2352 by 1568 pixels: 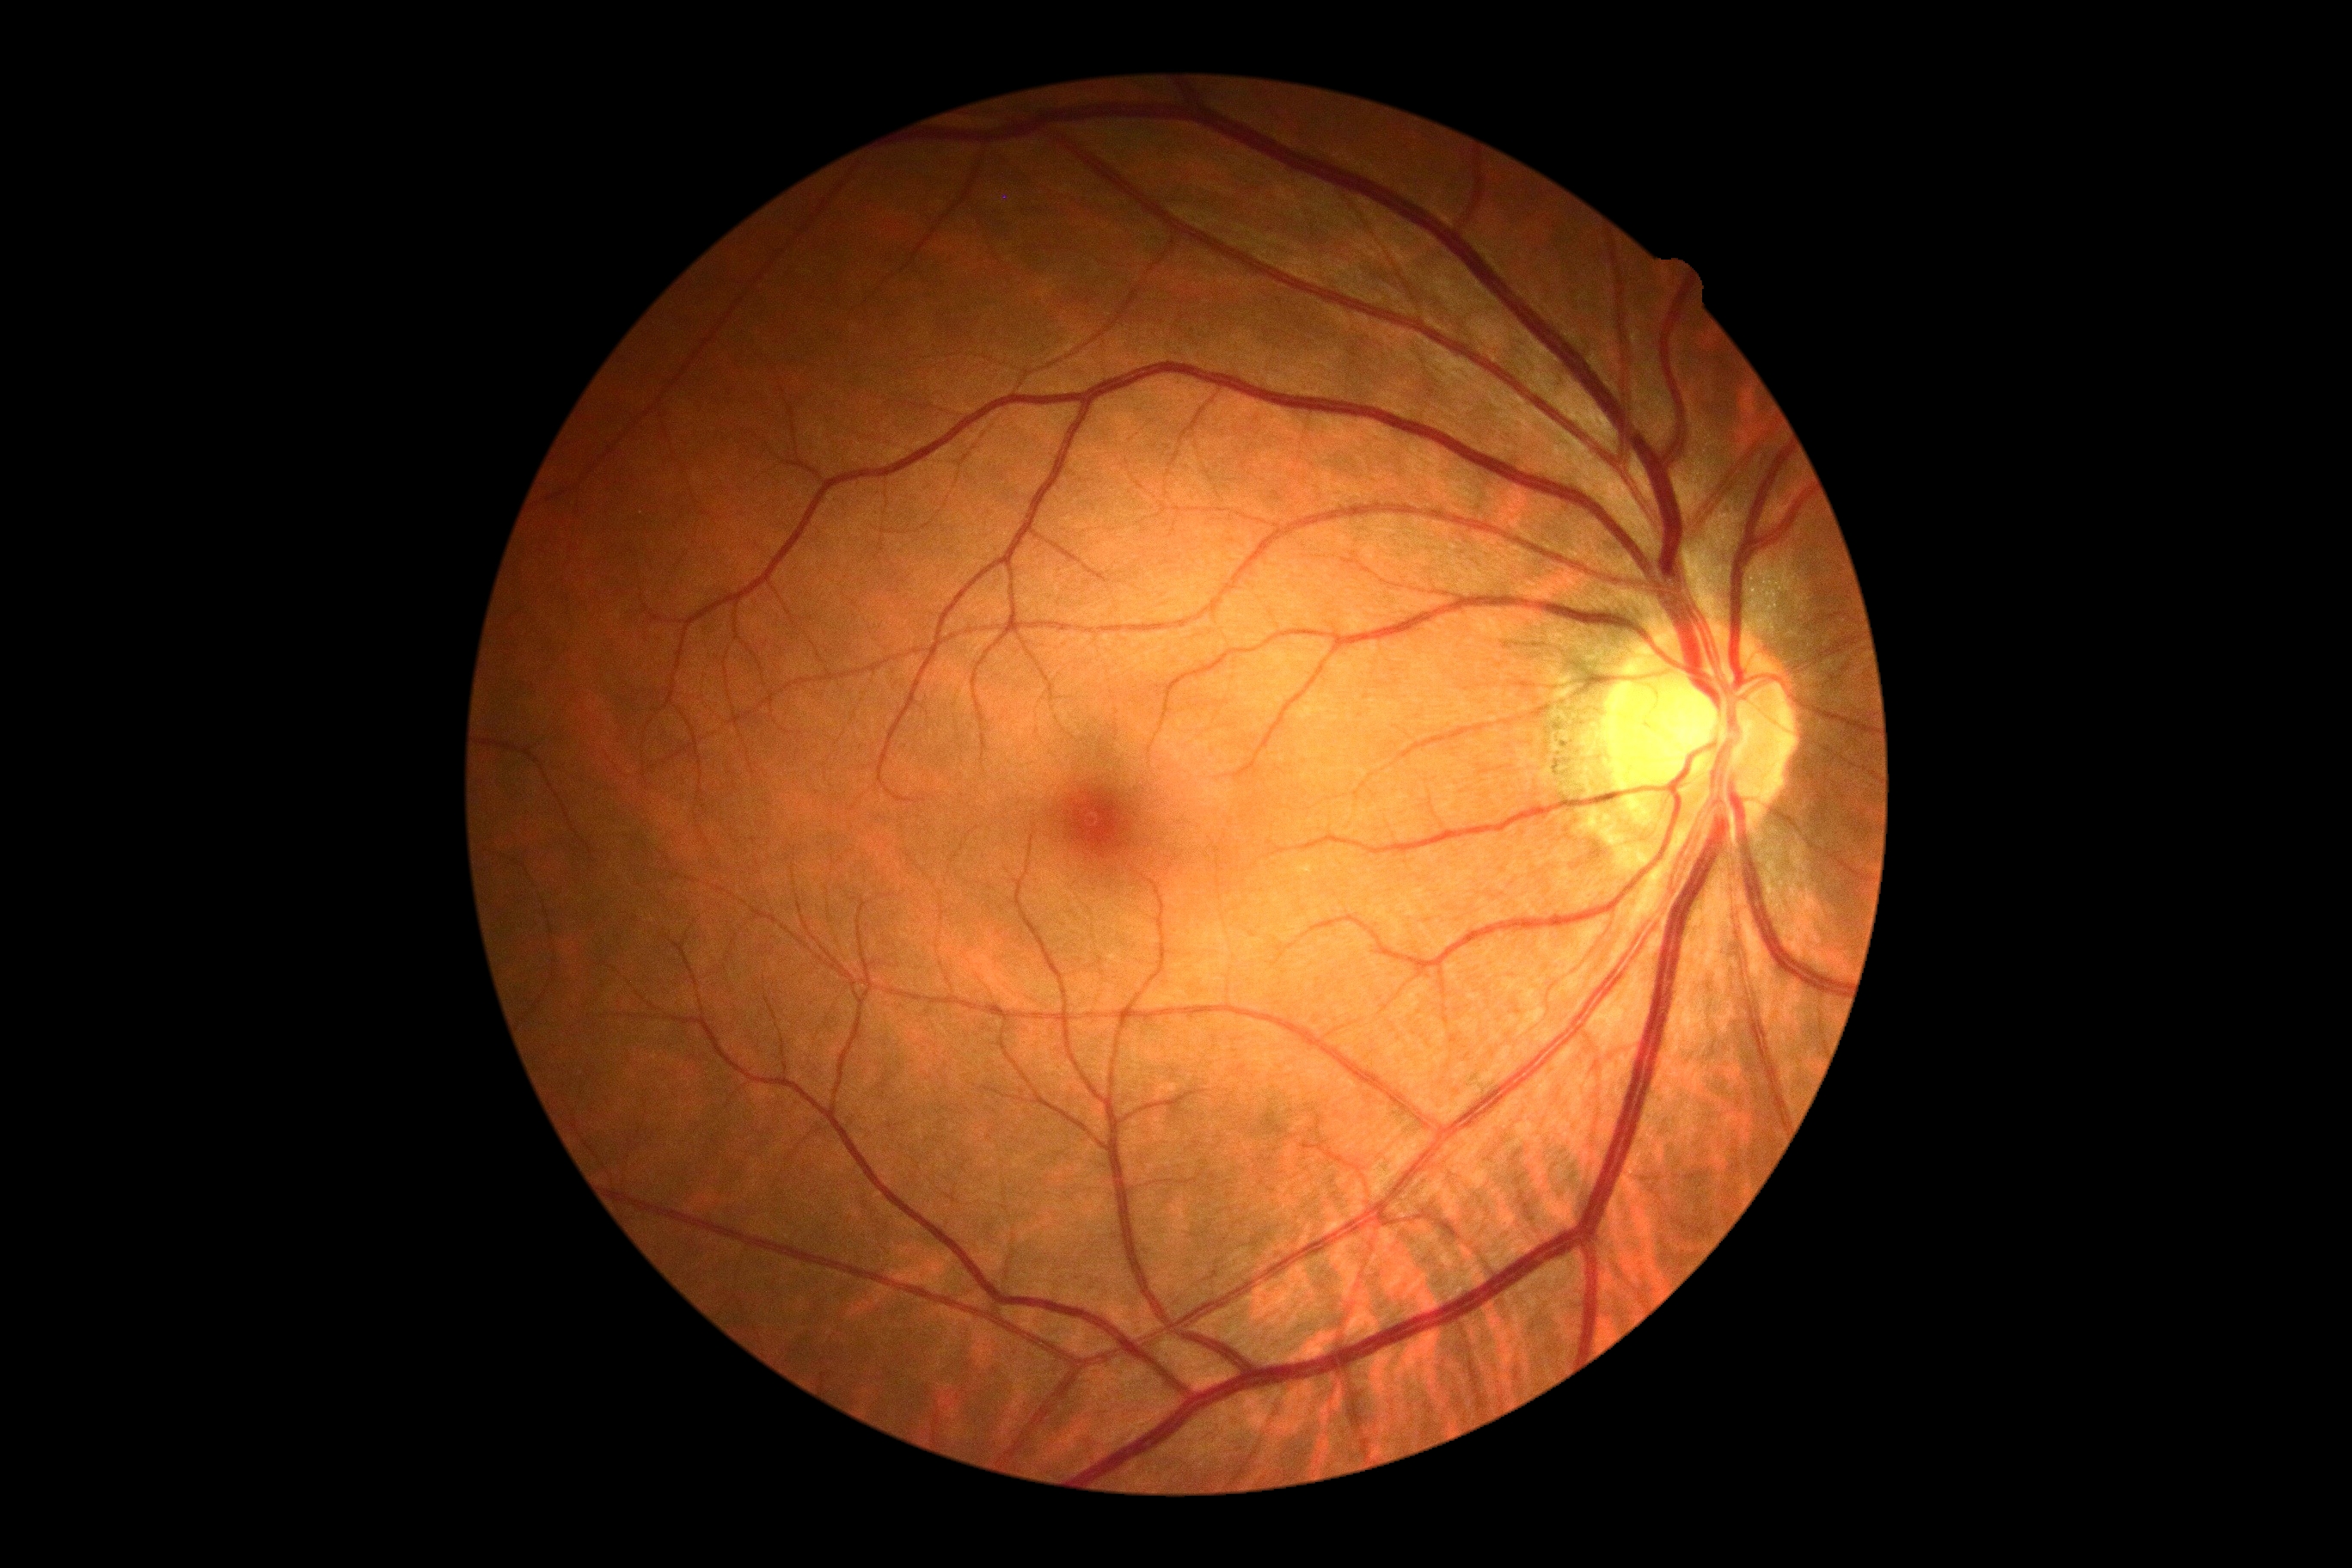
Diabetic retinopathy (DR): grade 0 (no apparent retinopathy).